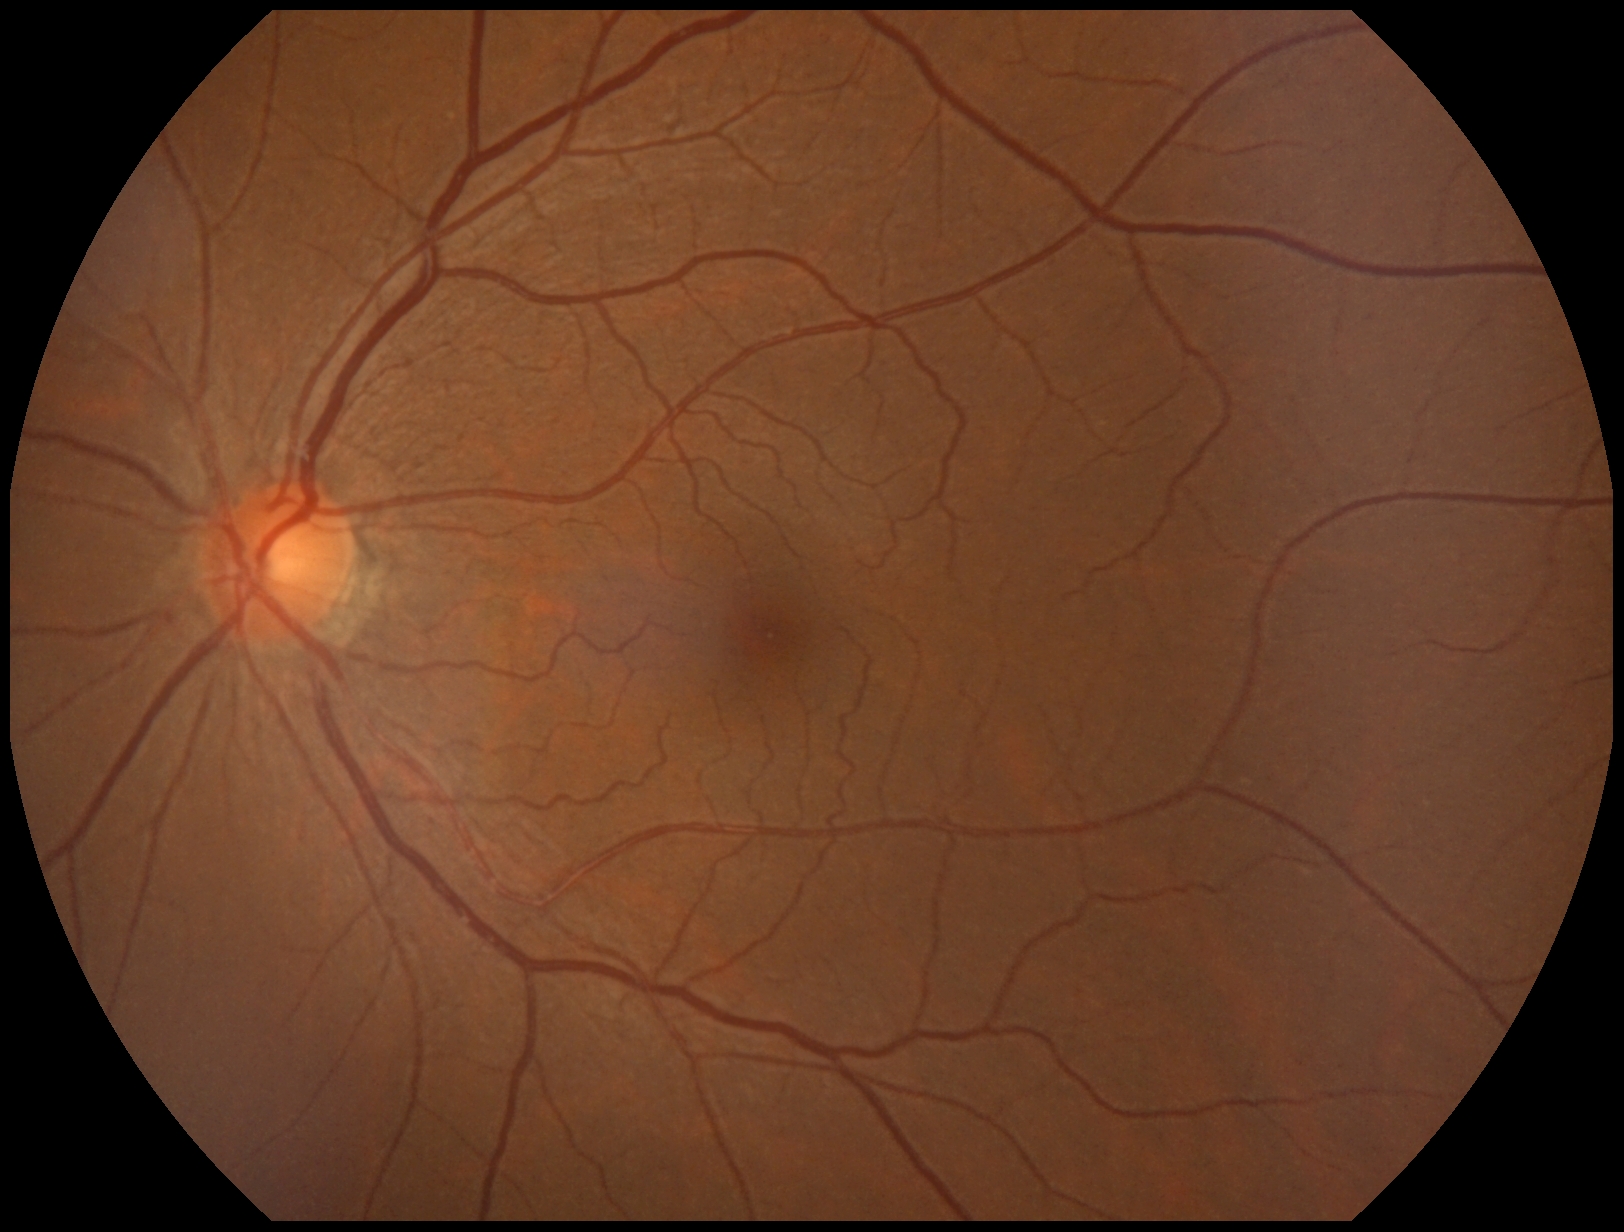 No signs of diabetic retinopathy.
Diabetic retinopathy grade: 0.